2228x1652
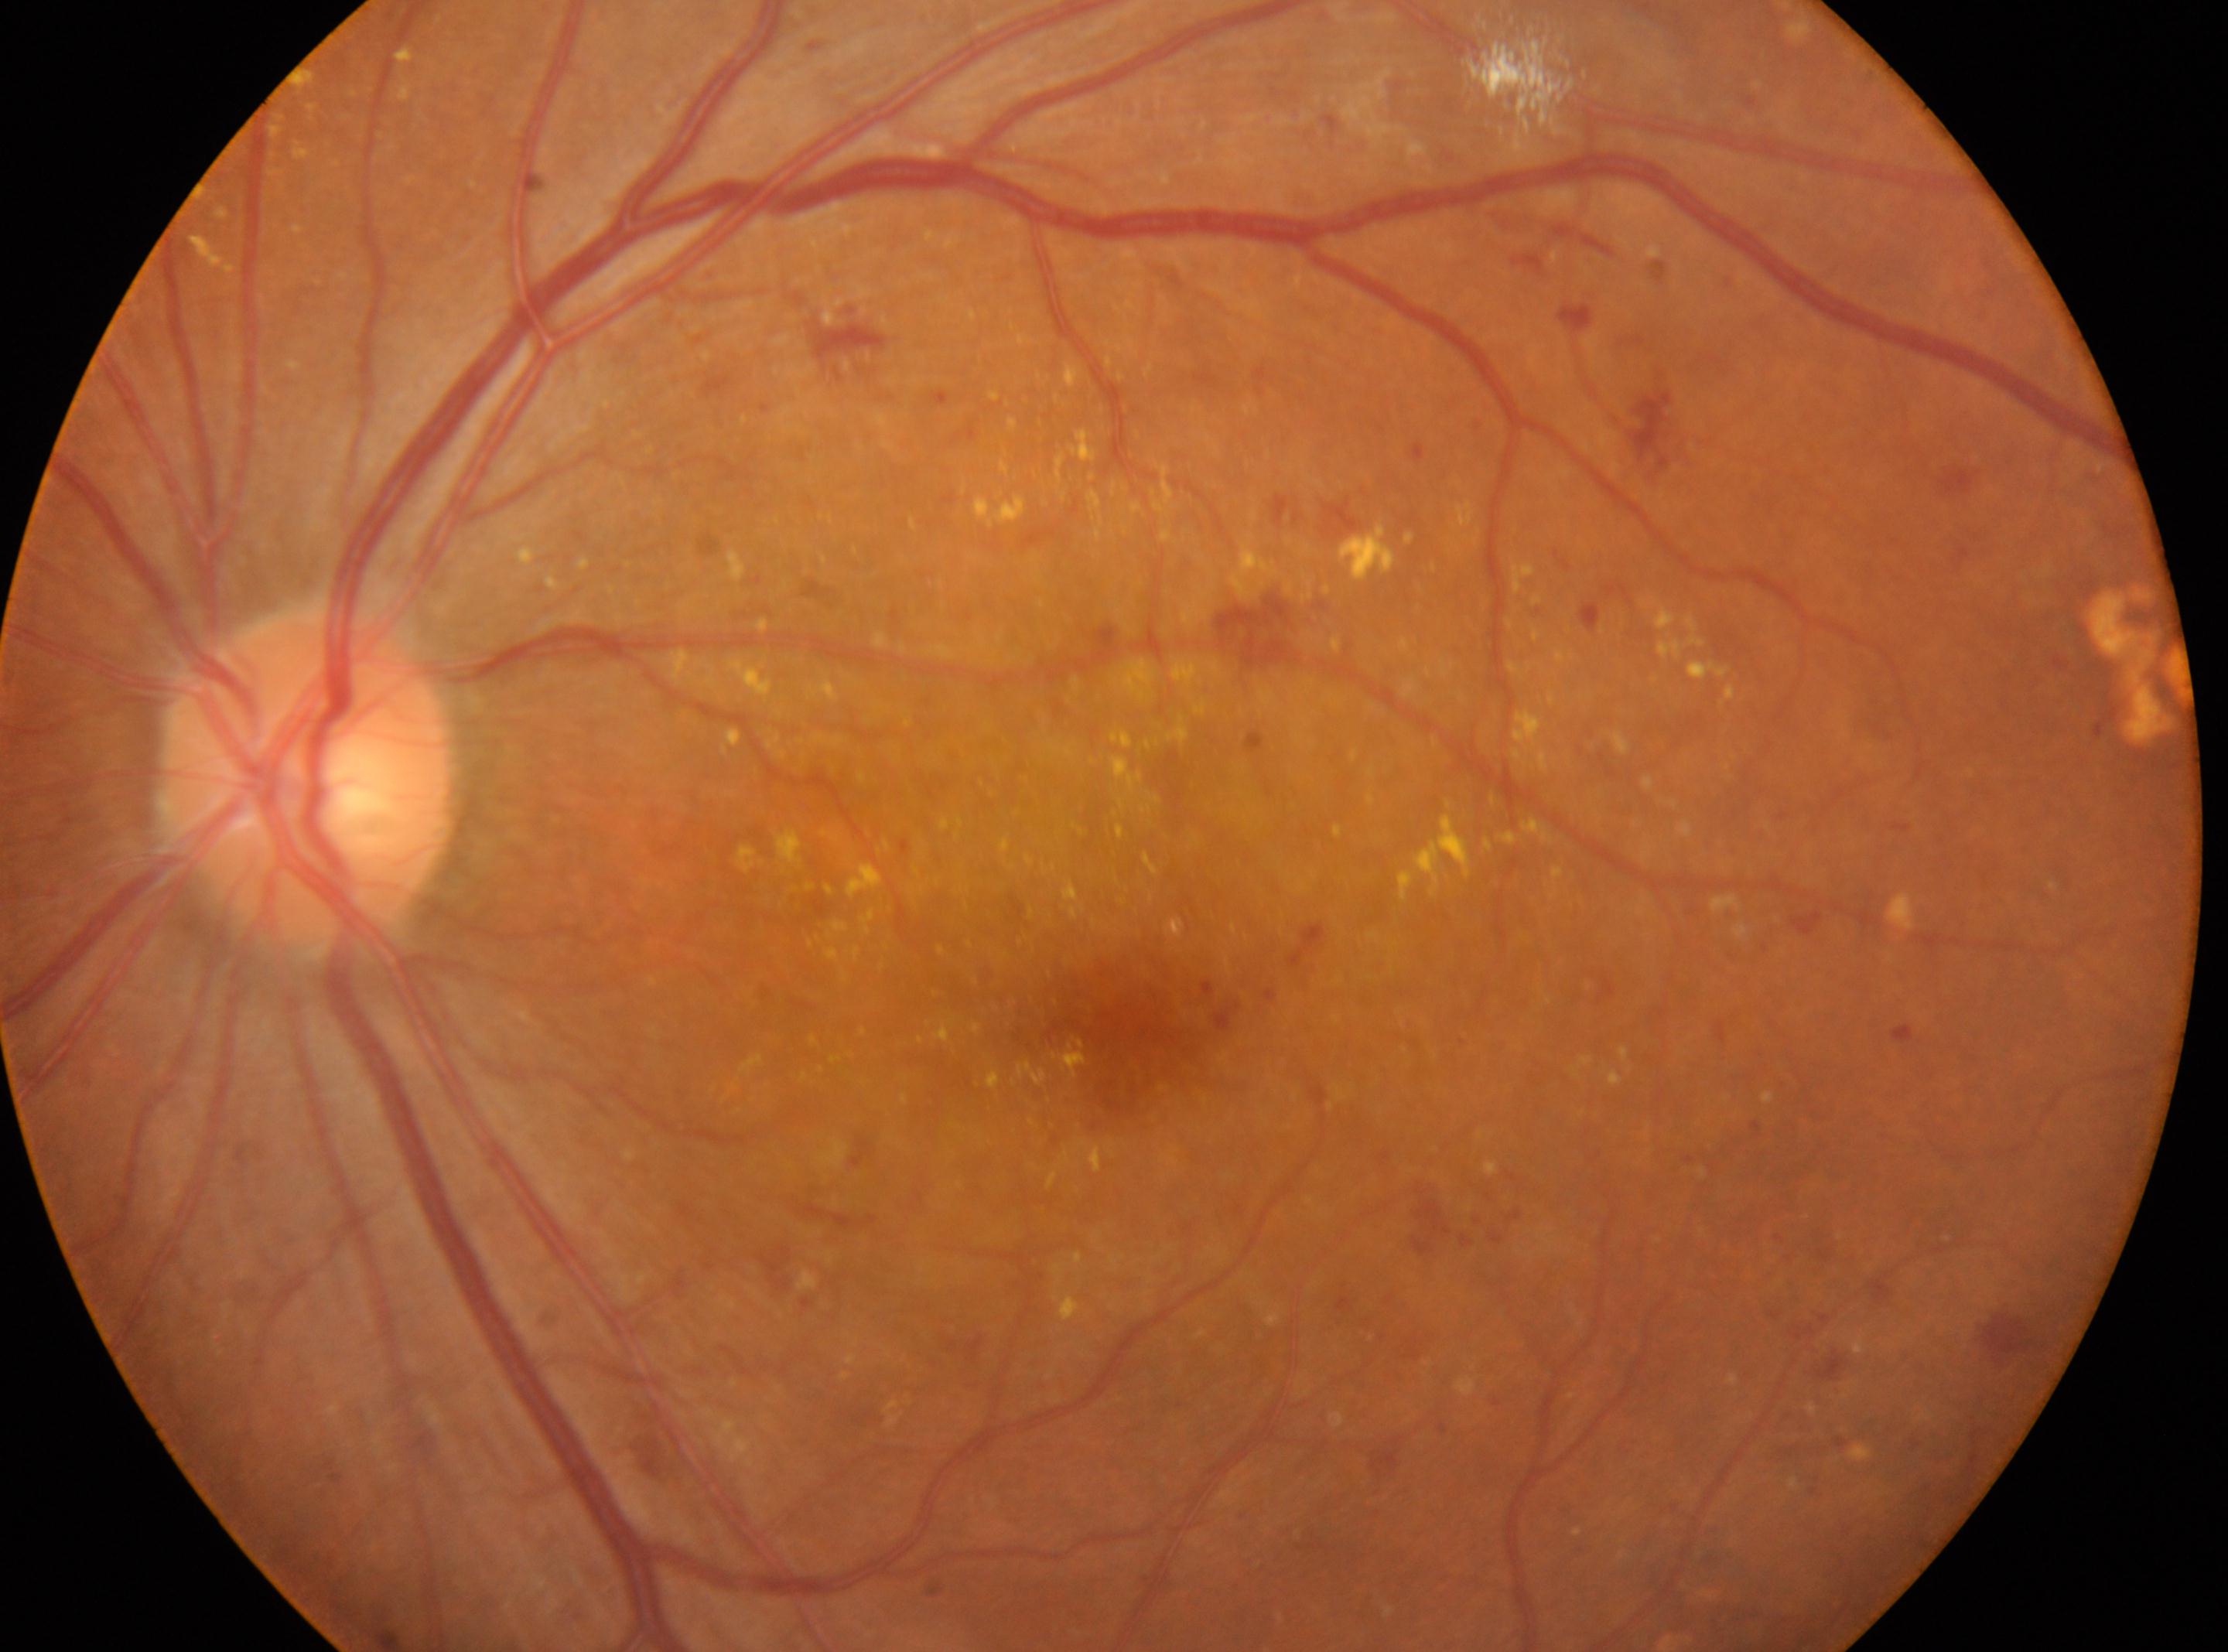 the fovea: 1133, 1030 | disc center: 306, 773 | laterality: the left eye | diabetic retinopathy severity: severe non-proliferative diabetic retinopathy (grade 3).